Wide-field fundus image from infant ROP screening.
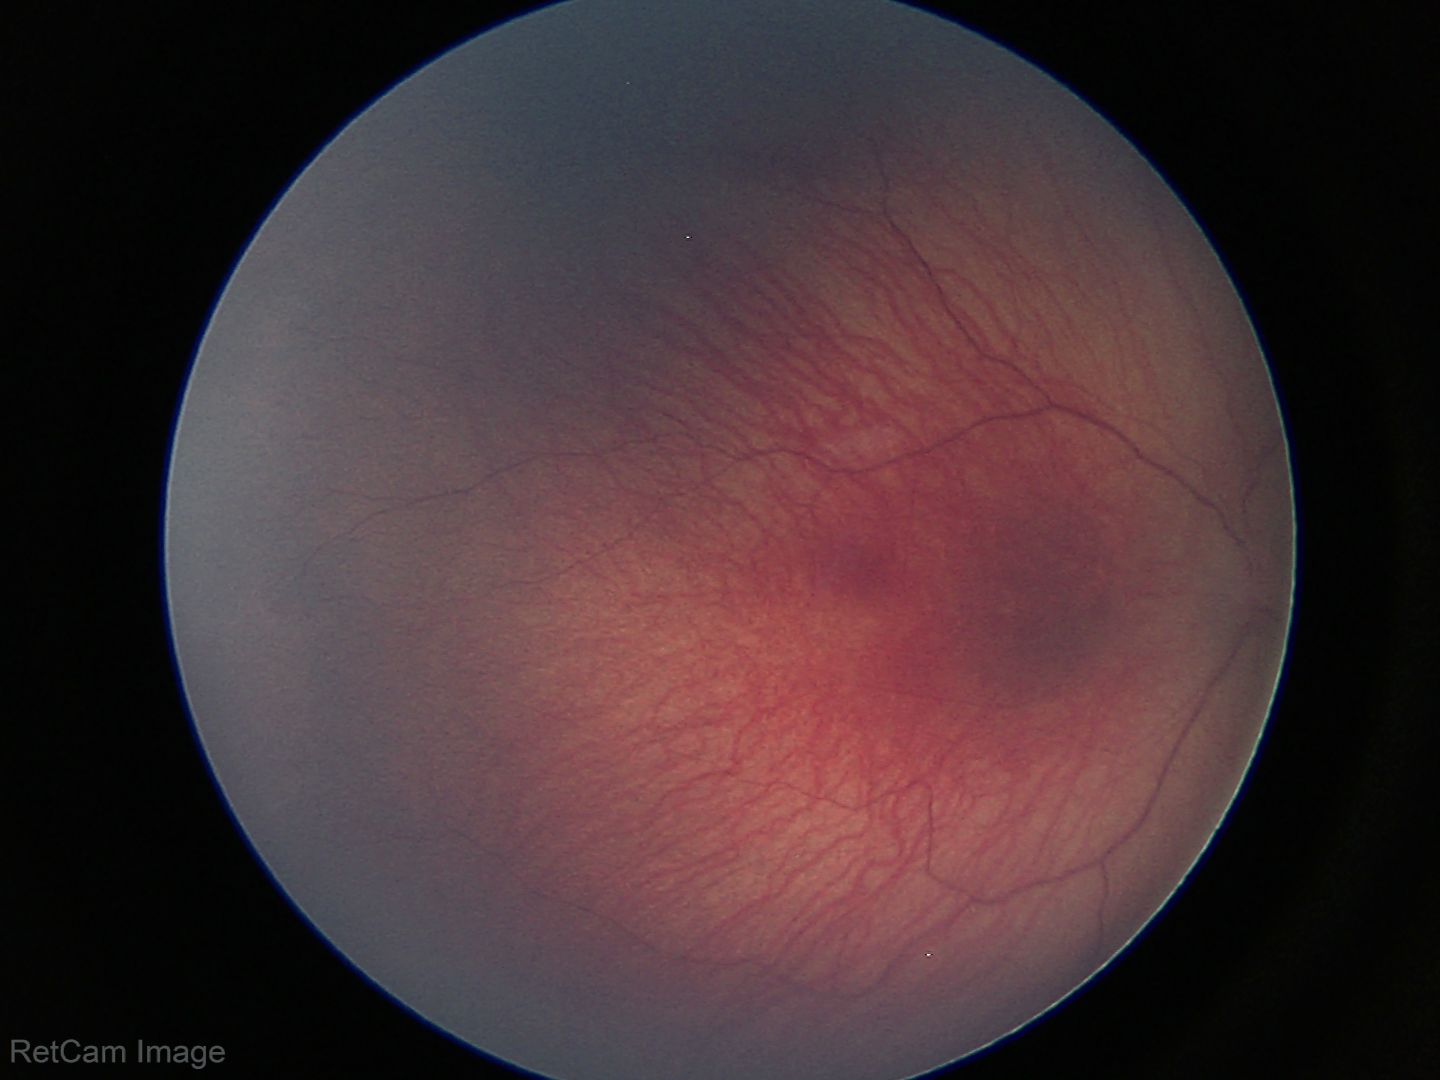

Without plus disease.
Examination diagnosed as retinopathy of prematurity (ROP) stage 1.